CFP. 2184x1690.
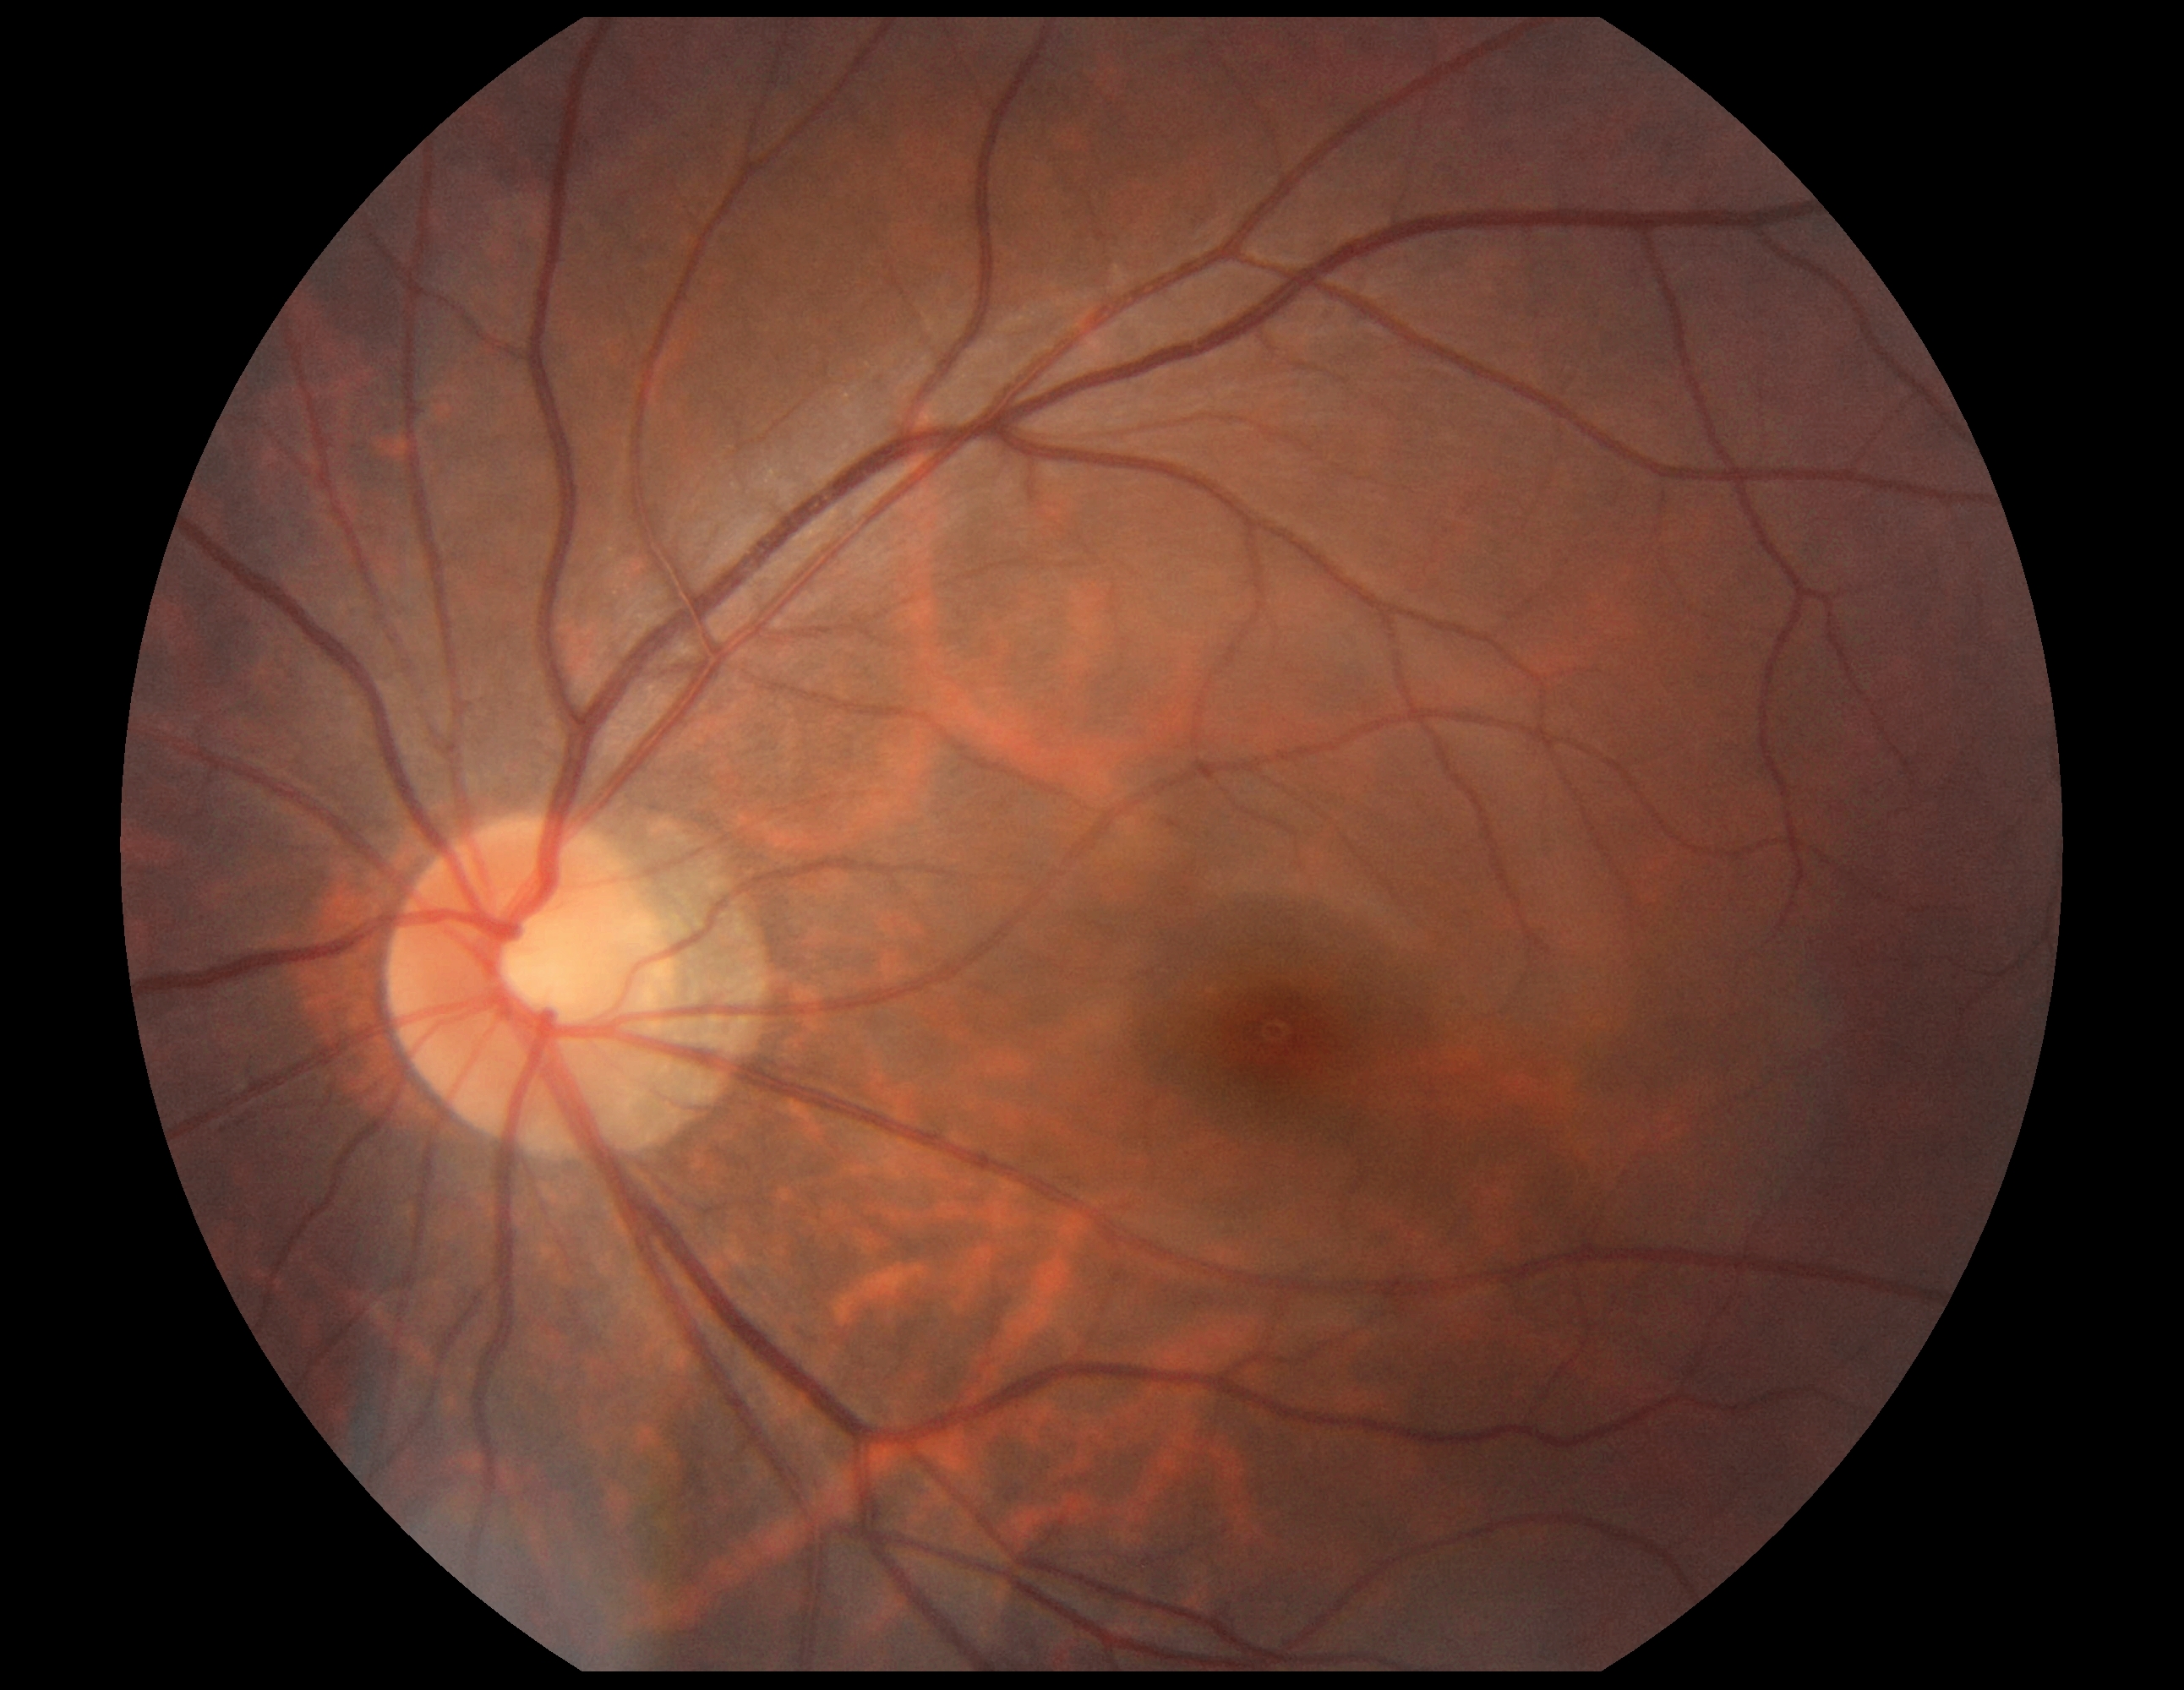

Retinopathy: 0/4. No signs of diabetic retinopathy.